Camera: Phoenix ICON (100° FOV). Infant wide-field retinal image:
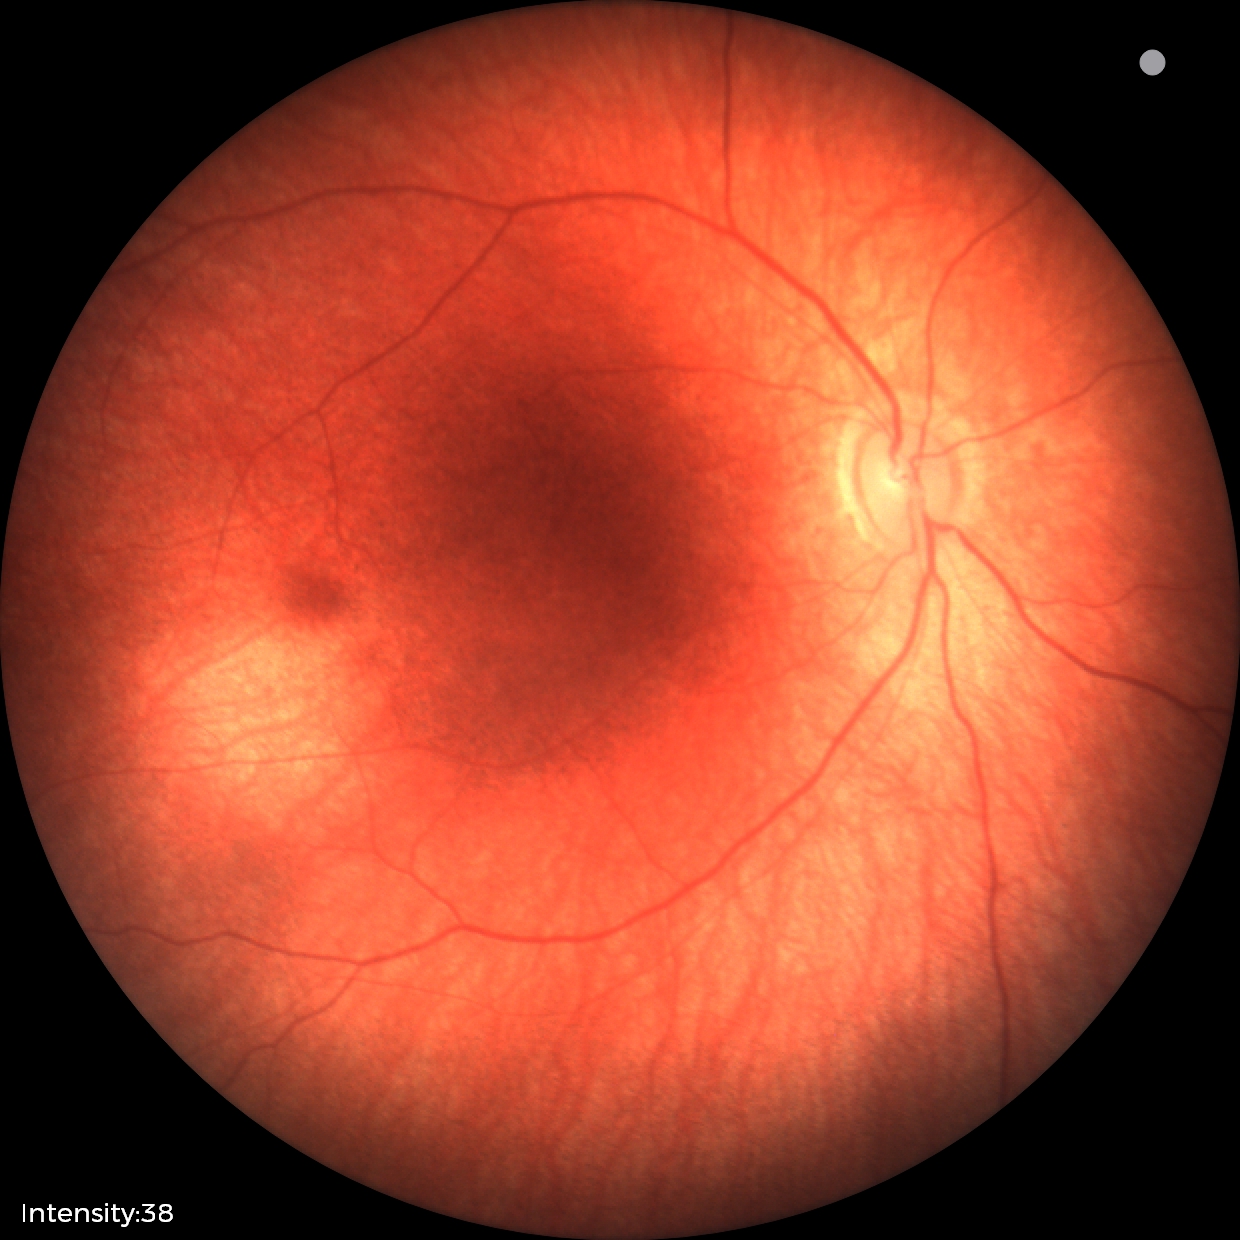
Assessment: physiological finding.